FOV: 45 degrees: 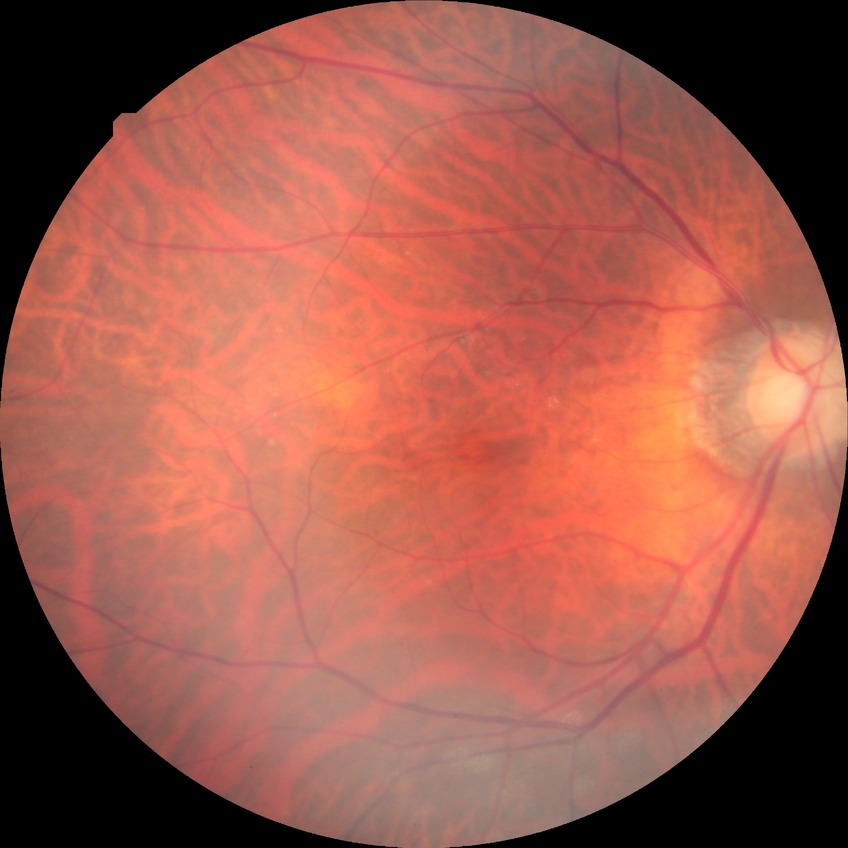

{
  "dr_impression": "no signs of DR",
  "davis_grade": "NDR"
}